45-degree field of view:
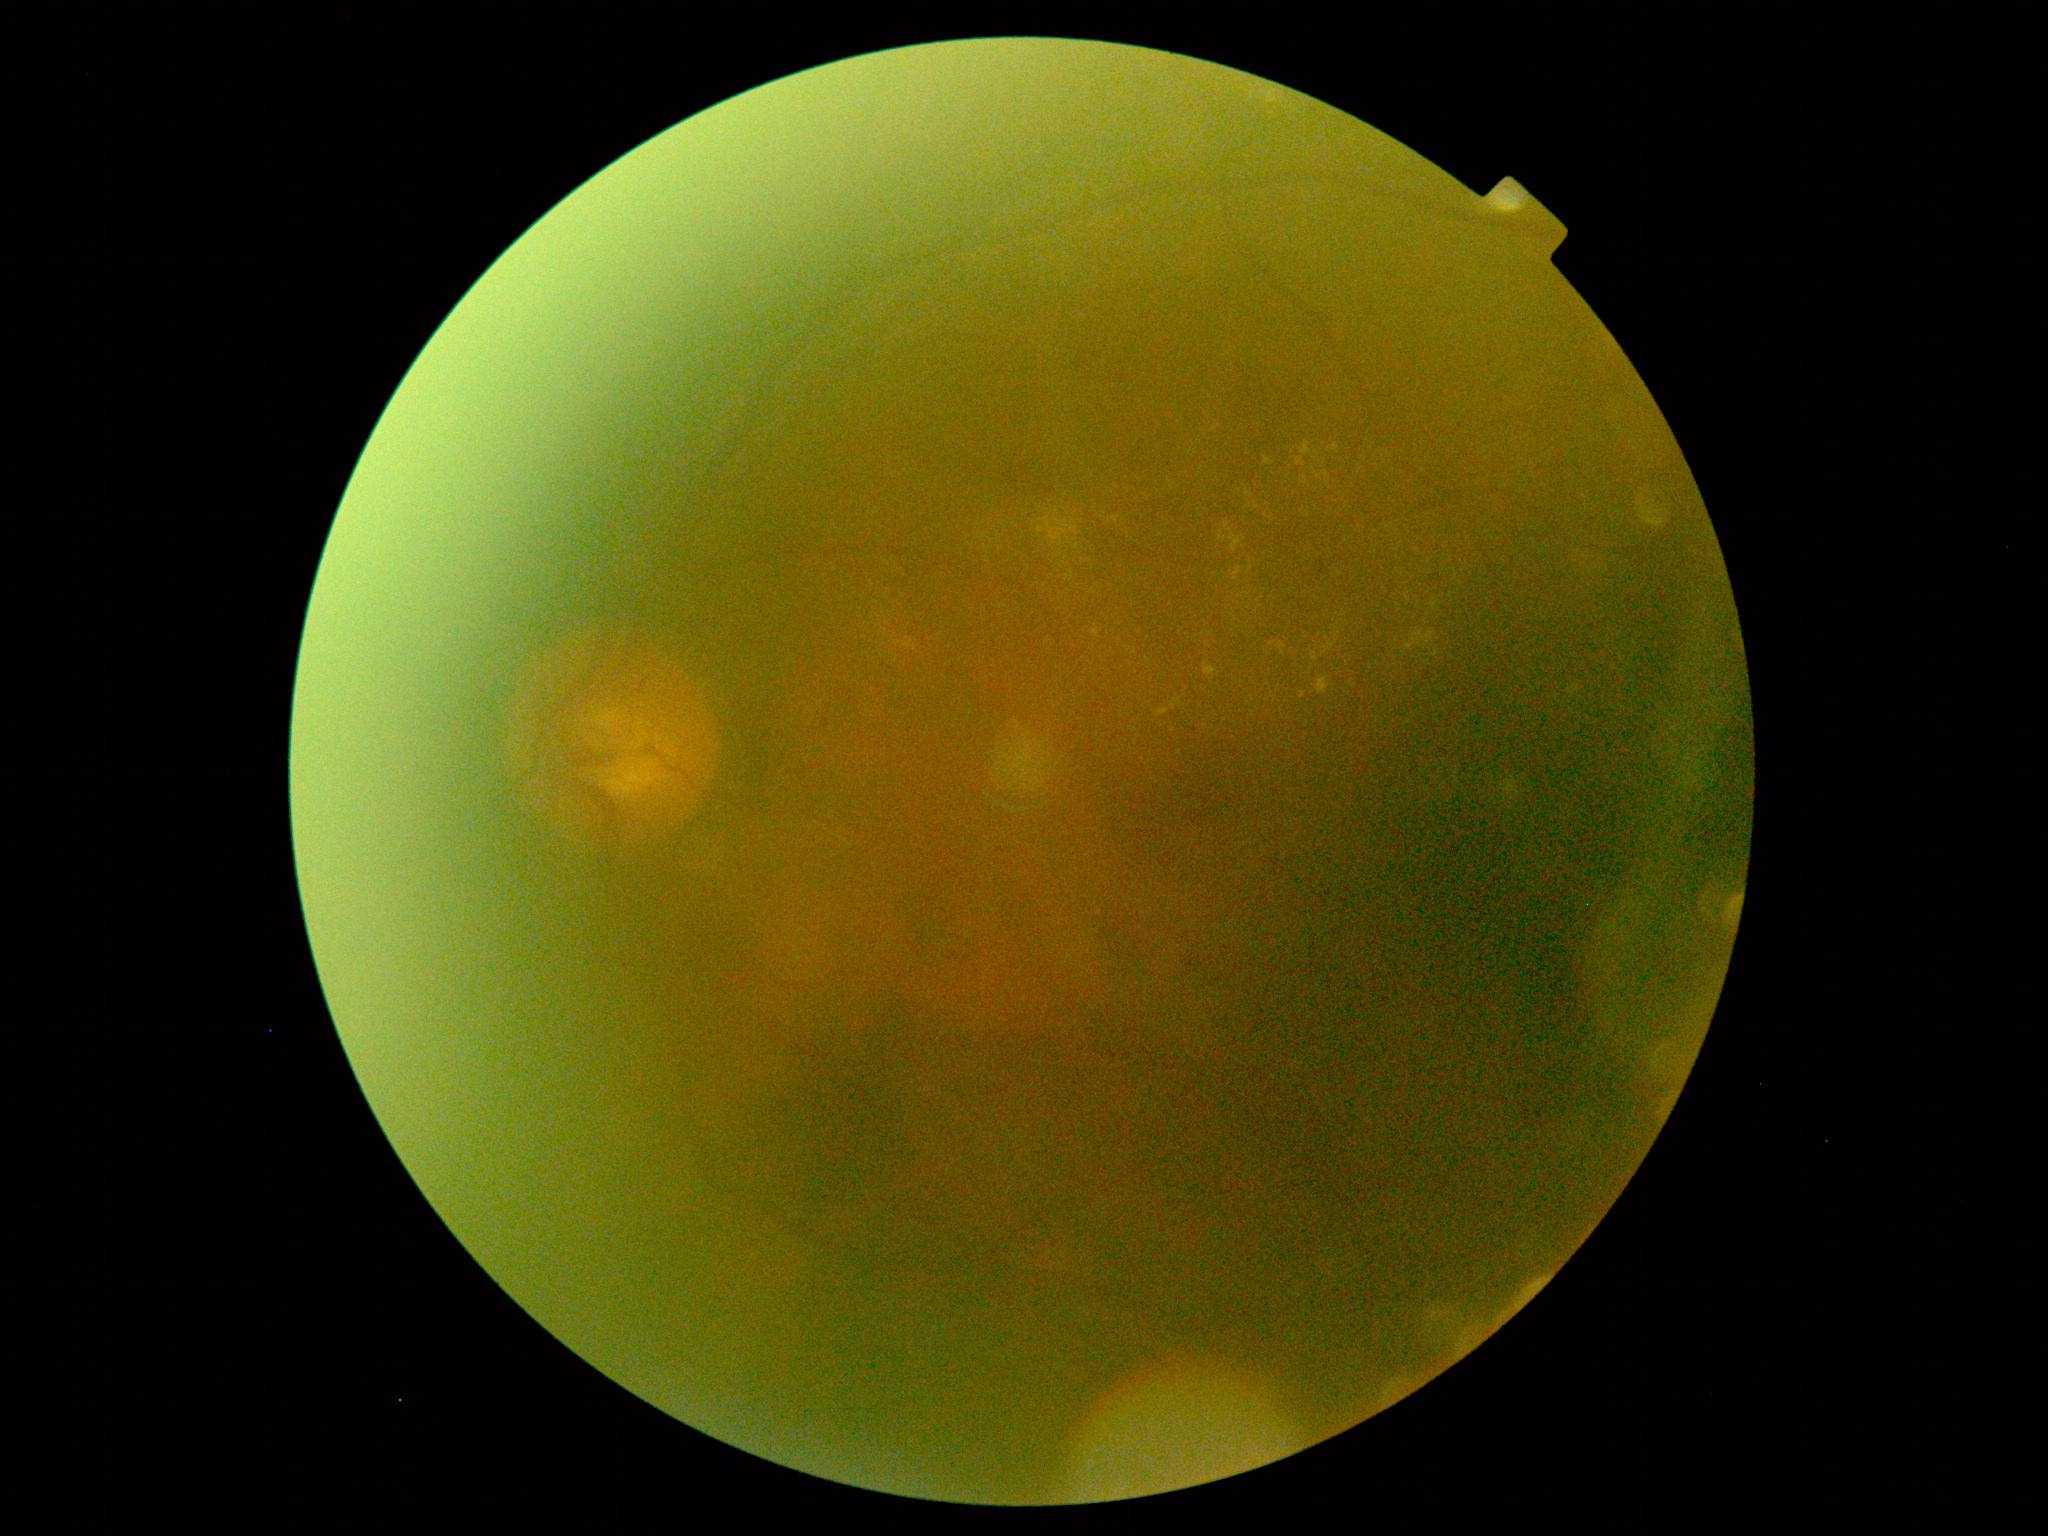
* diabetic retinopathy severity: 2